Retinal fundus photograph — 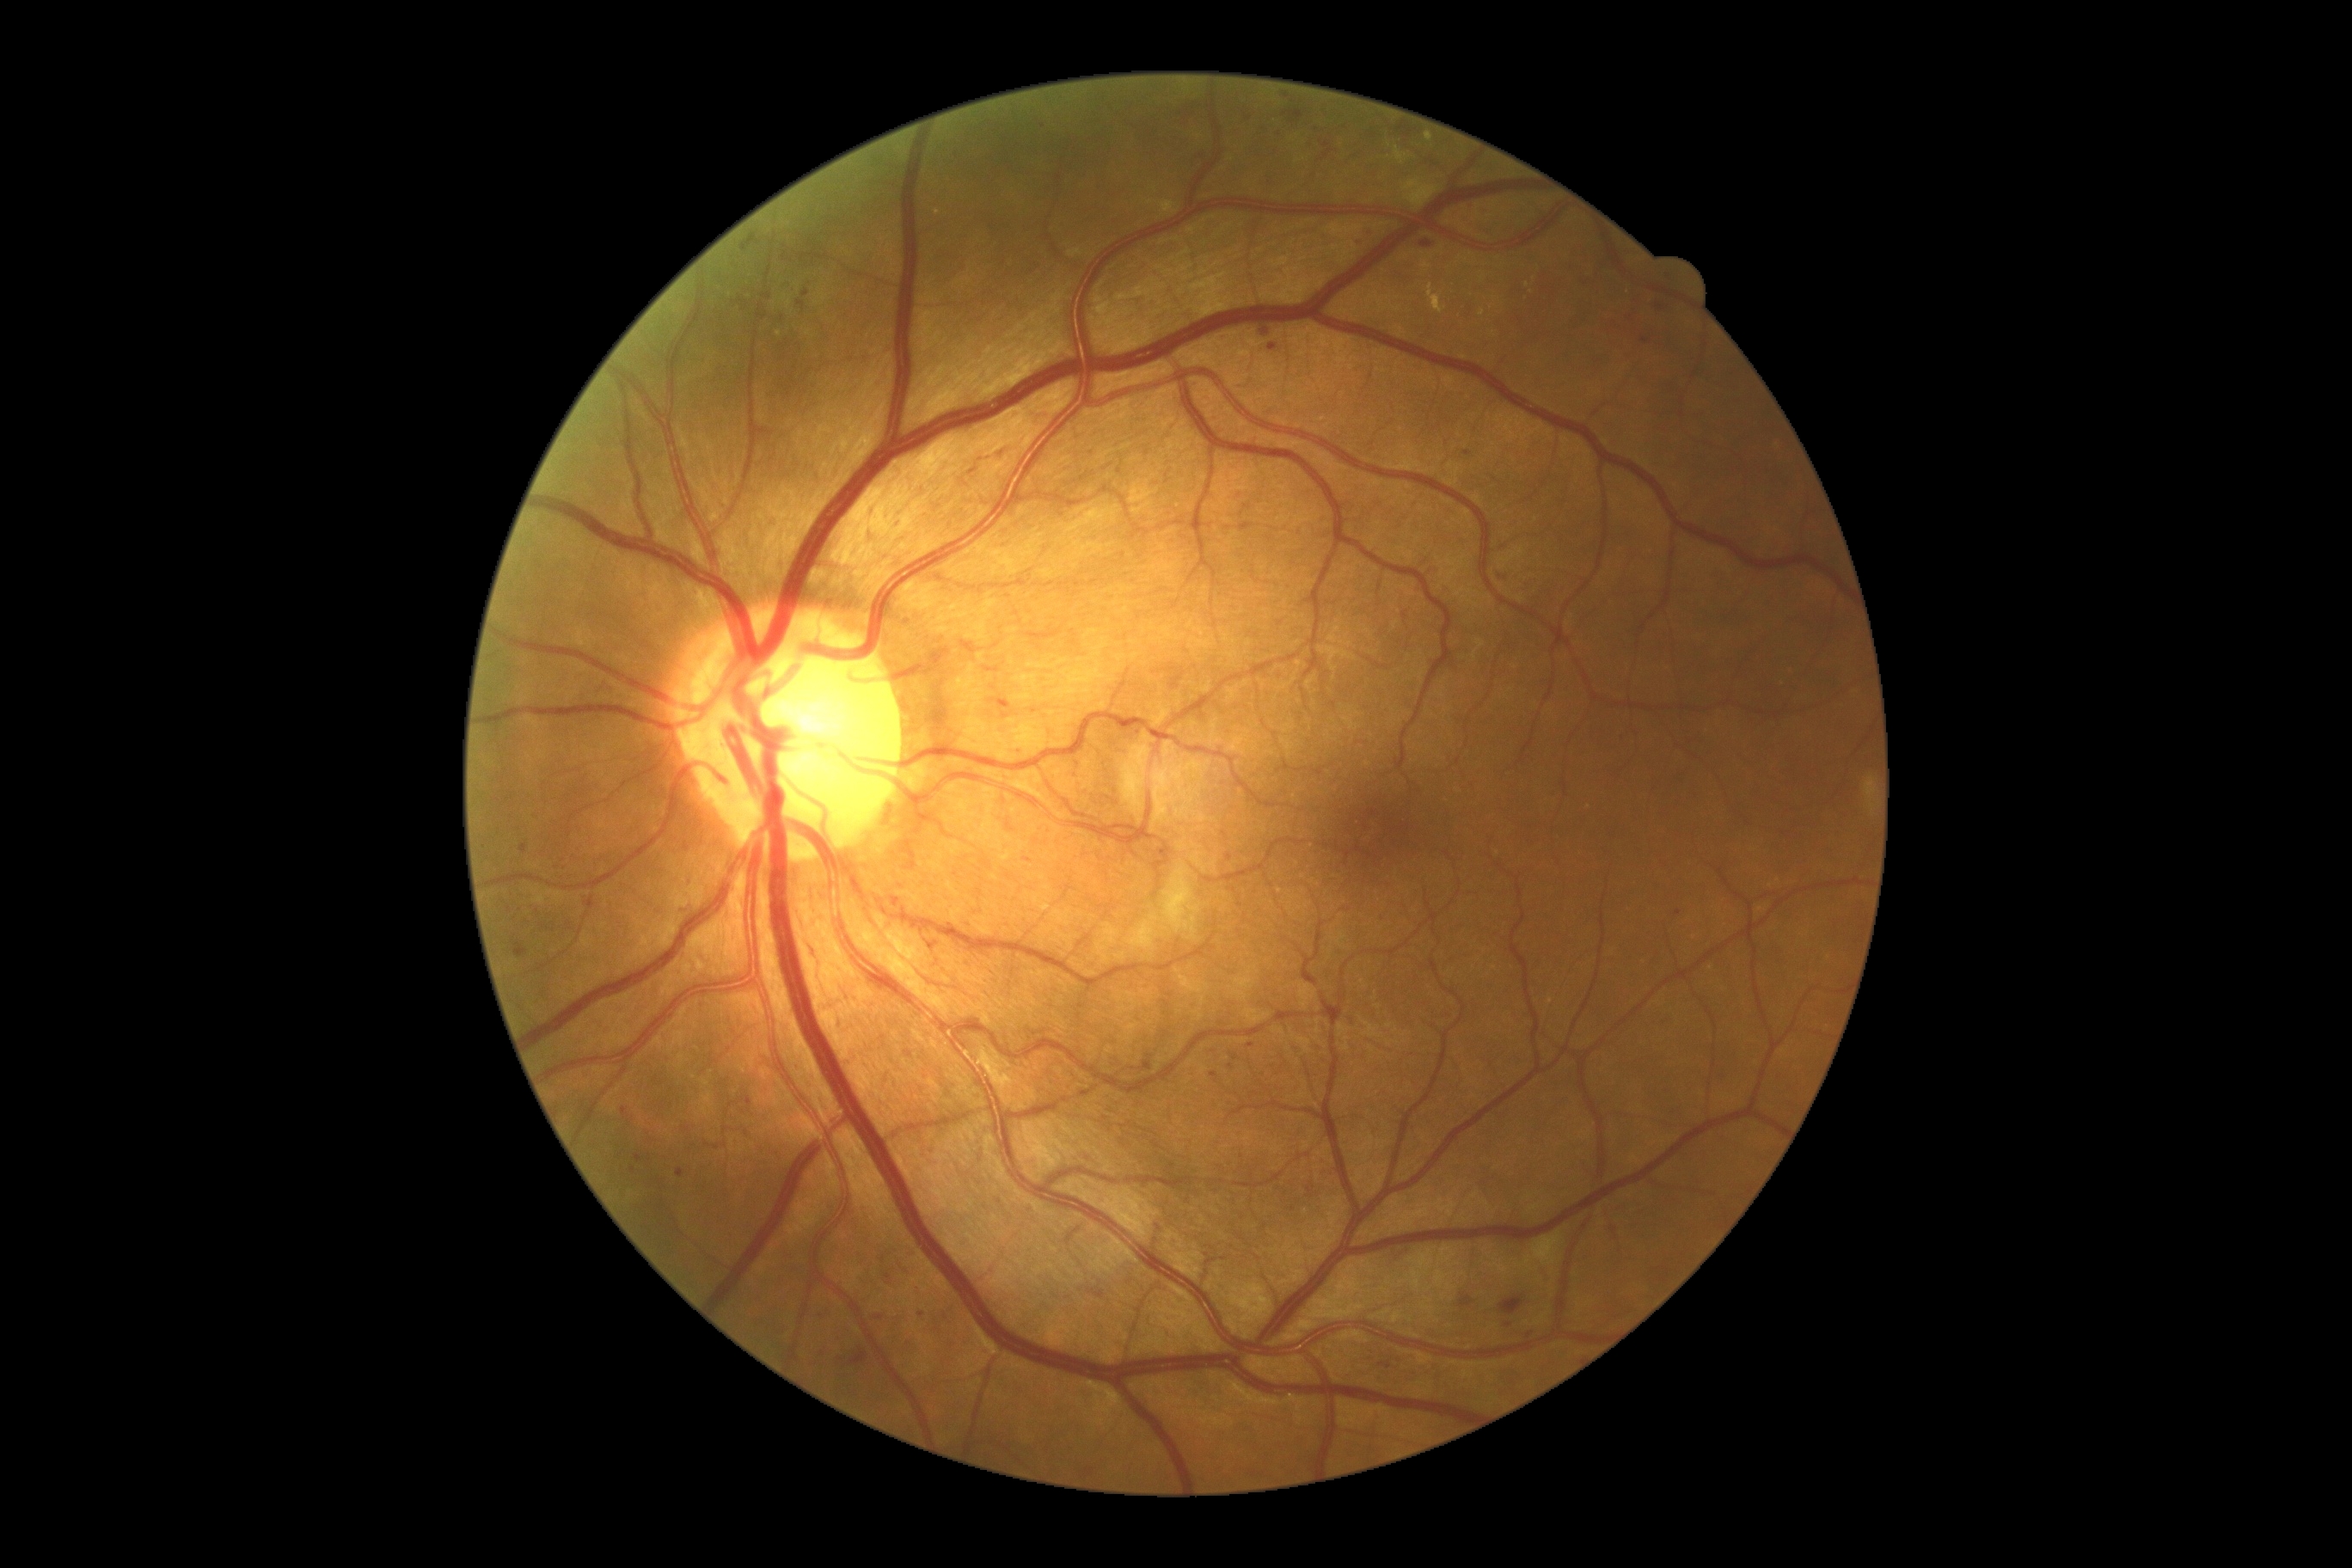 DR grade: moderate NPDR (2) — more than just microaneurysms but less than severe NPDR. MAs include those at l=895, t=522, r=903, b=527; l=520, t=845, r=527, b=854; l=740, t=235, r=761, b=252; l=1459, t=1294, r=1474, b=1309; l=677, t=1170, r=685, b=1179; l=797, t=300, r=805, b=312; l=1479, t=209, r=1488, b=216. Additional small MAs near 689:886; 1230:857; 1161:853; 1287:97; 1528:1336; 888:1277; 1678:914; 1660:307; 1139:733.